2352x1568:
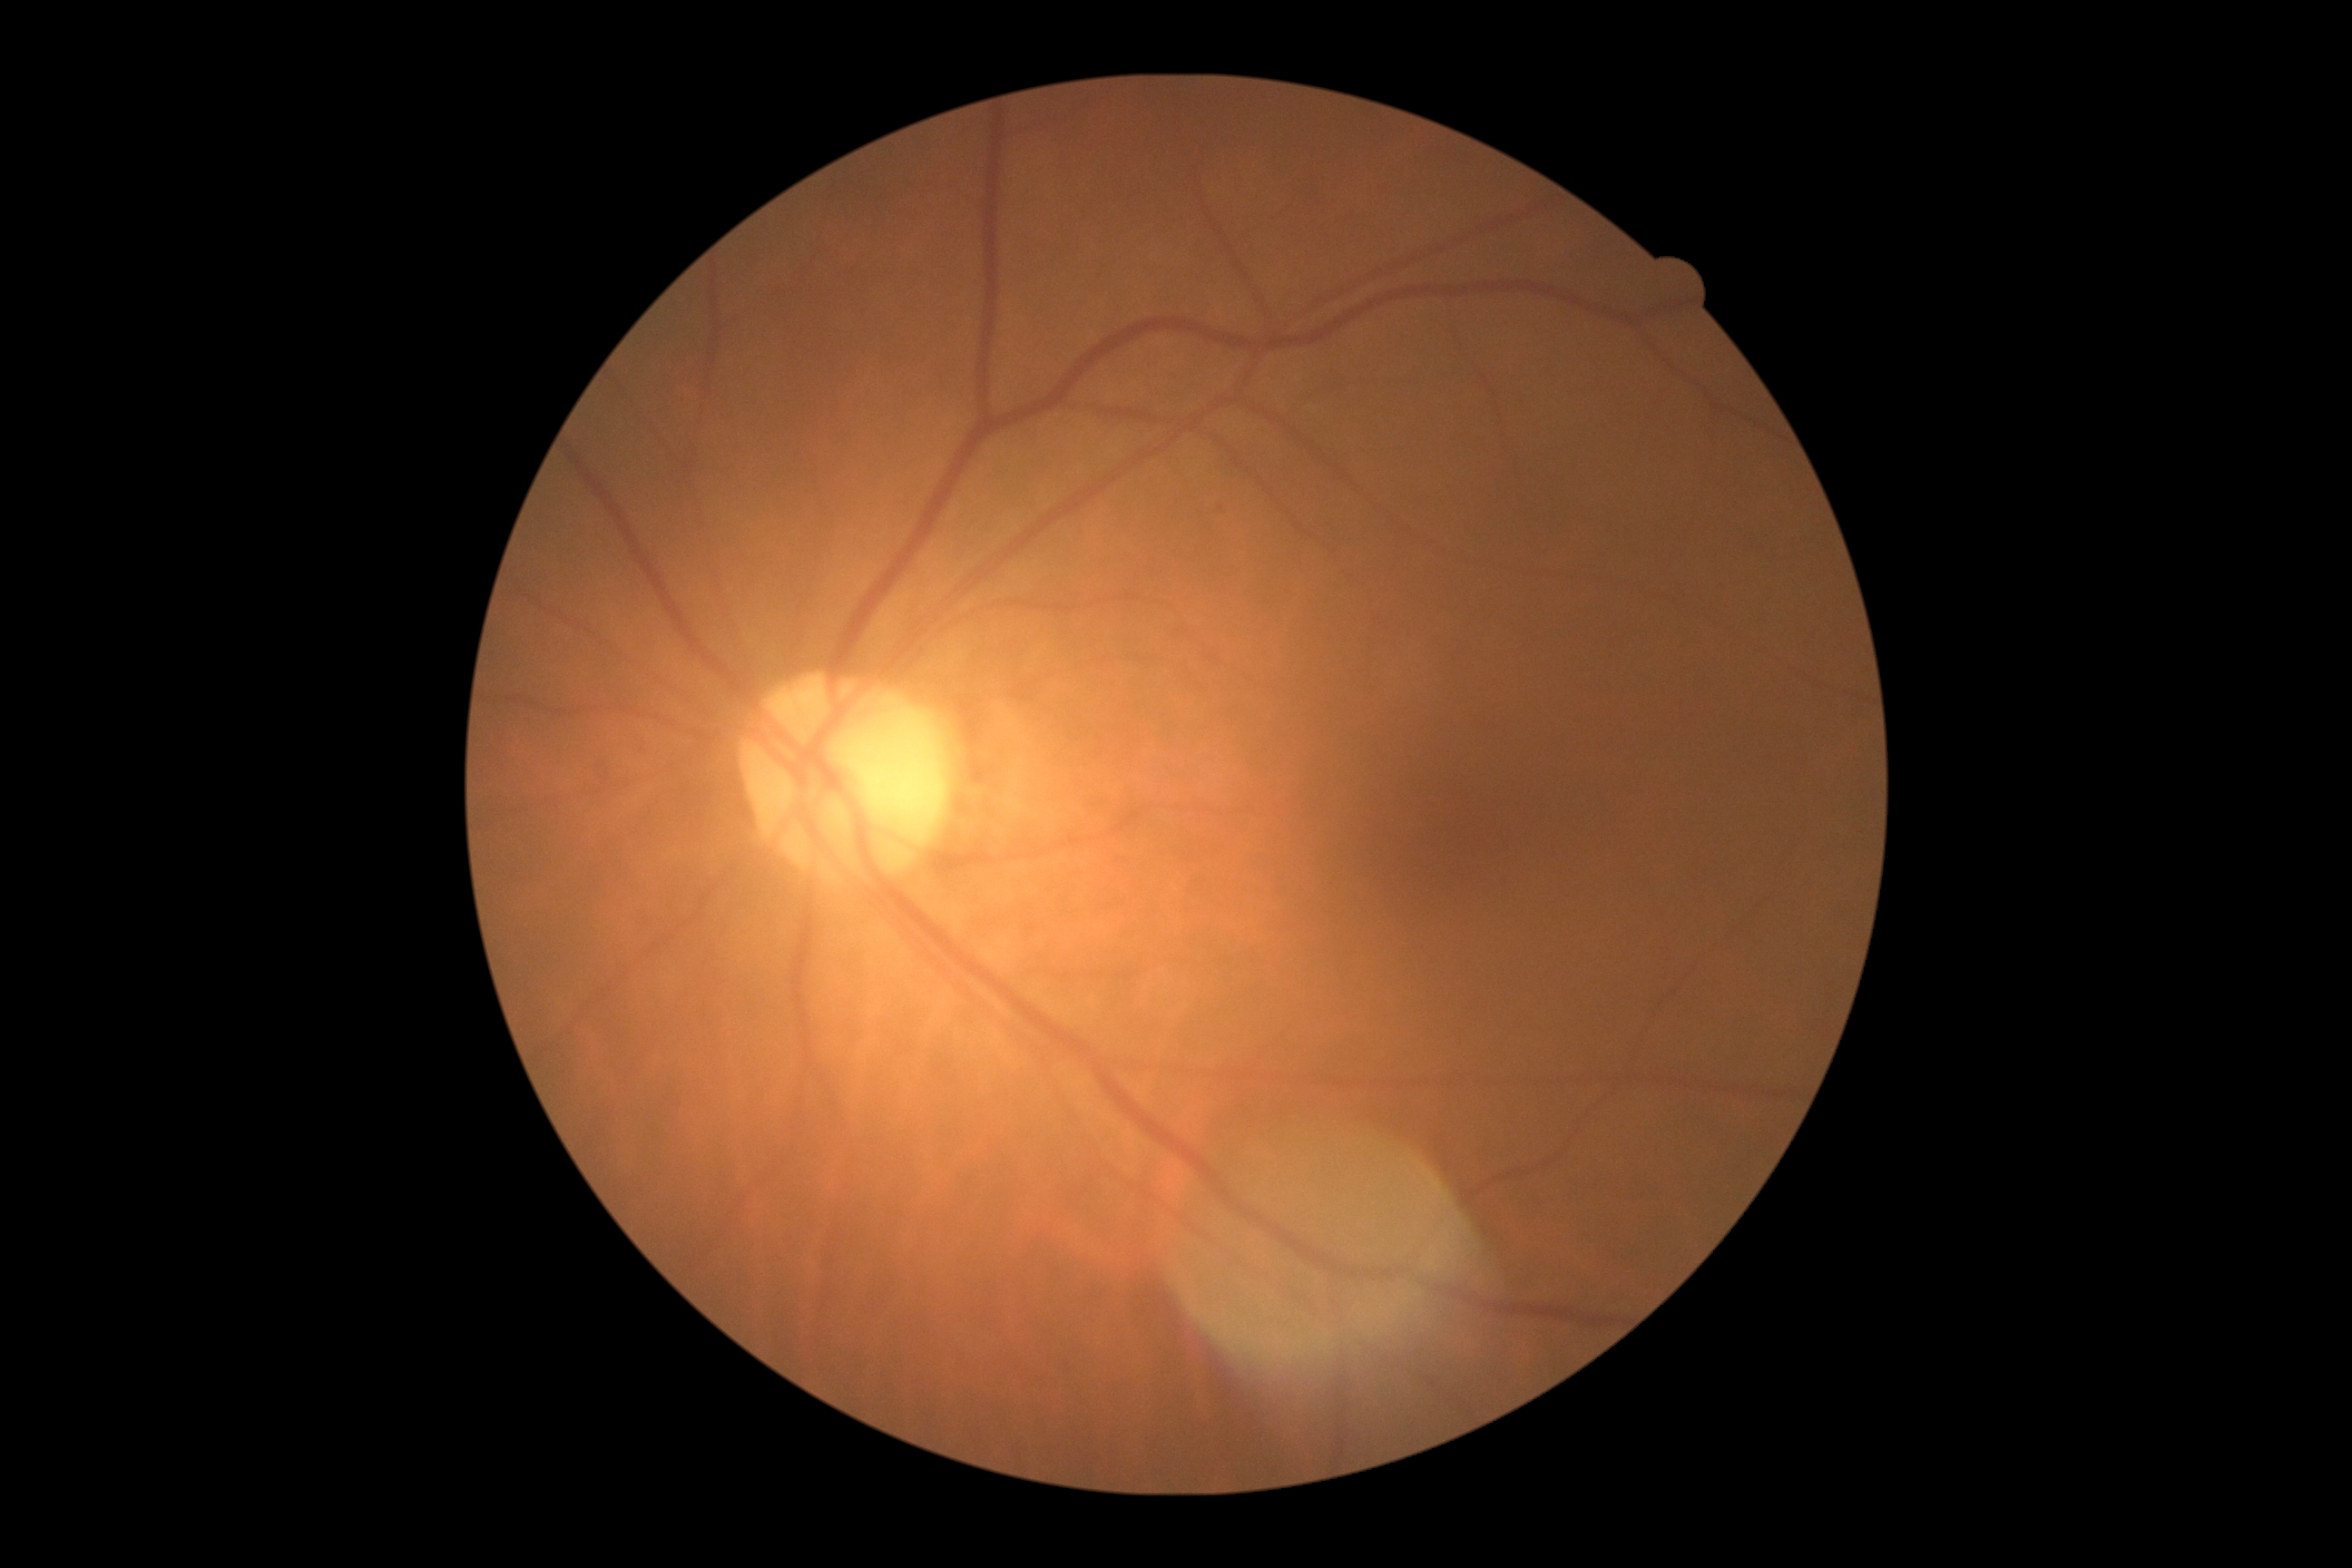 The retinopathy is classified as non-proliferative diabetic retinopathy. DR stage: 1/4.